Retinal fundus photograph; DR severity per modified Davis staging: 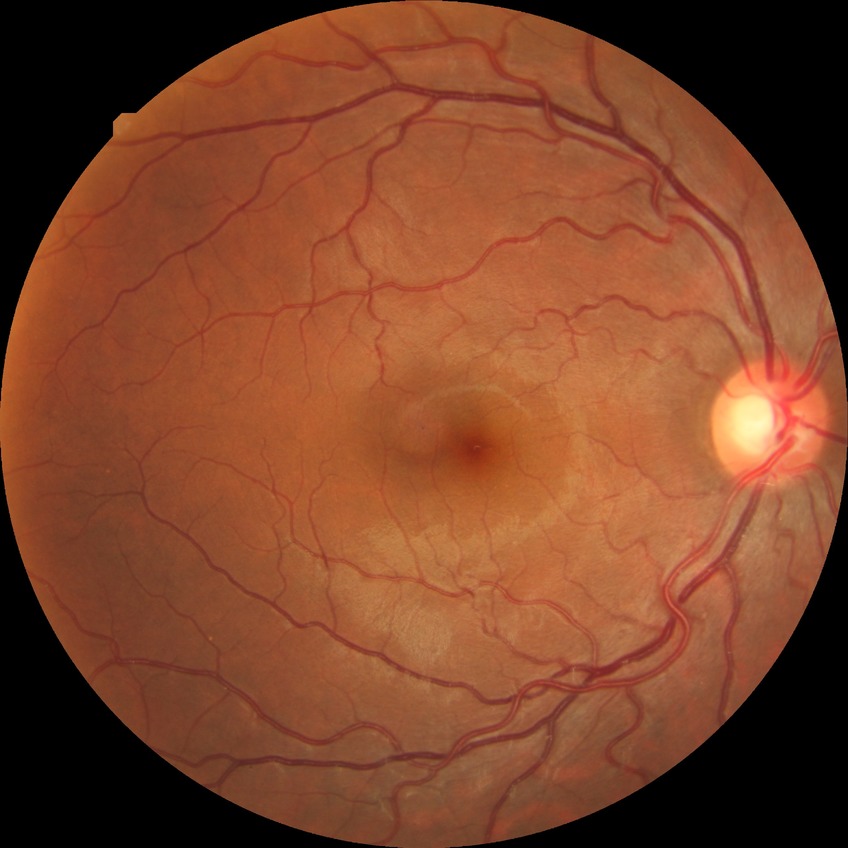

diabetic retinopathy severity: no diabetic retinopathy.